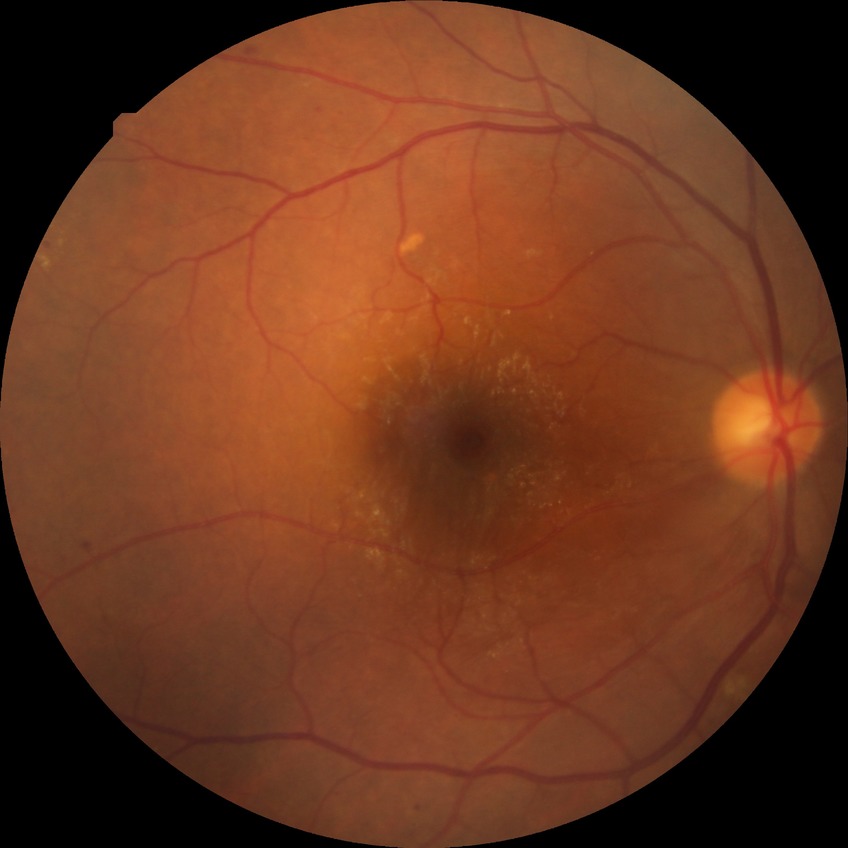

Diabetic retinopathy (DR) is simple diabetic retinopathy (SDR).